Non-mydriatic acquisition: 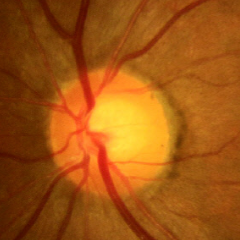
Optic nerve head appearance consistent with no glaucomatous findings.